Color fundus image — 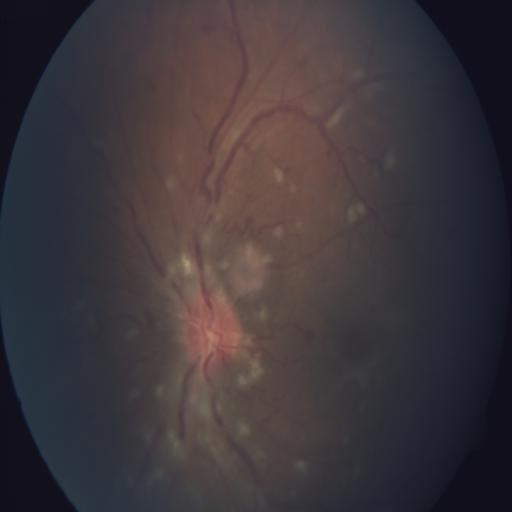 Pathology: optic disc edema; cotton wool spots.